Davis DR grading: 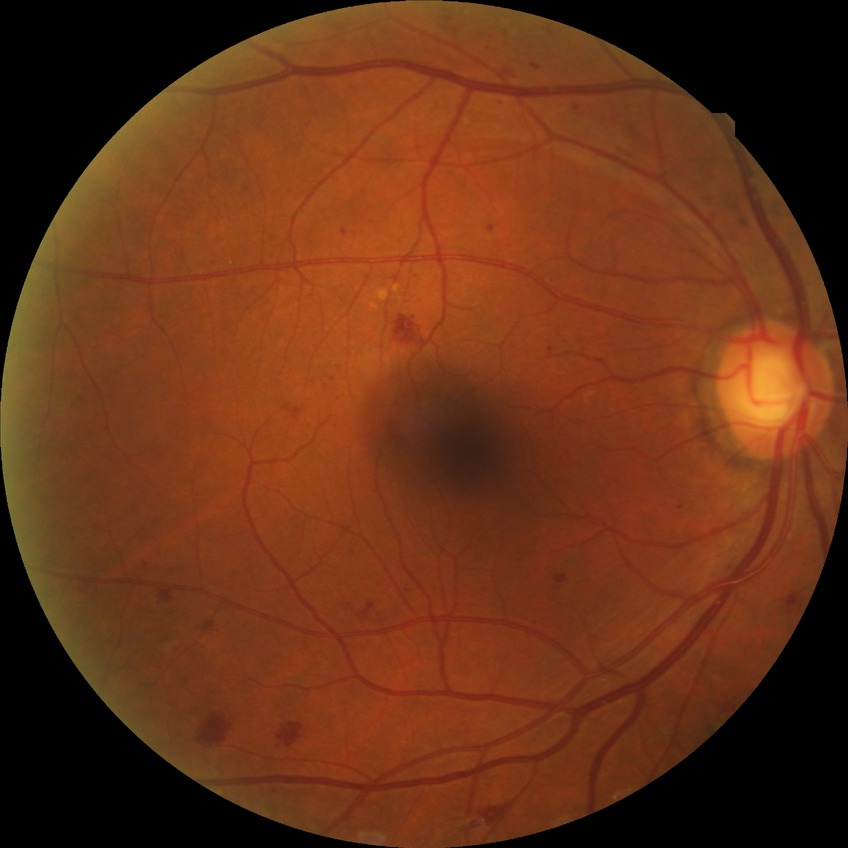
diabetic retinopathy (DR): SDR (simple diabetic retinopathy).